Infant wide-field retinal image; camera: Phoenix ICON (100° FOV); 1240x1240:
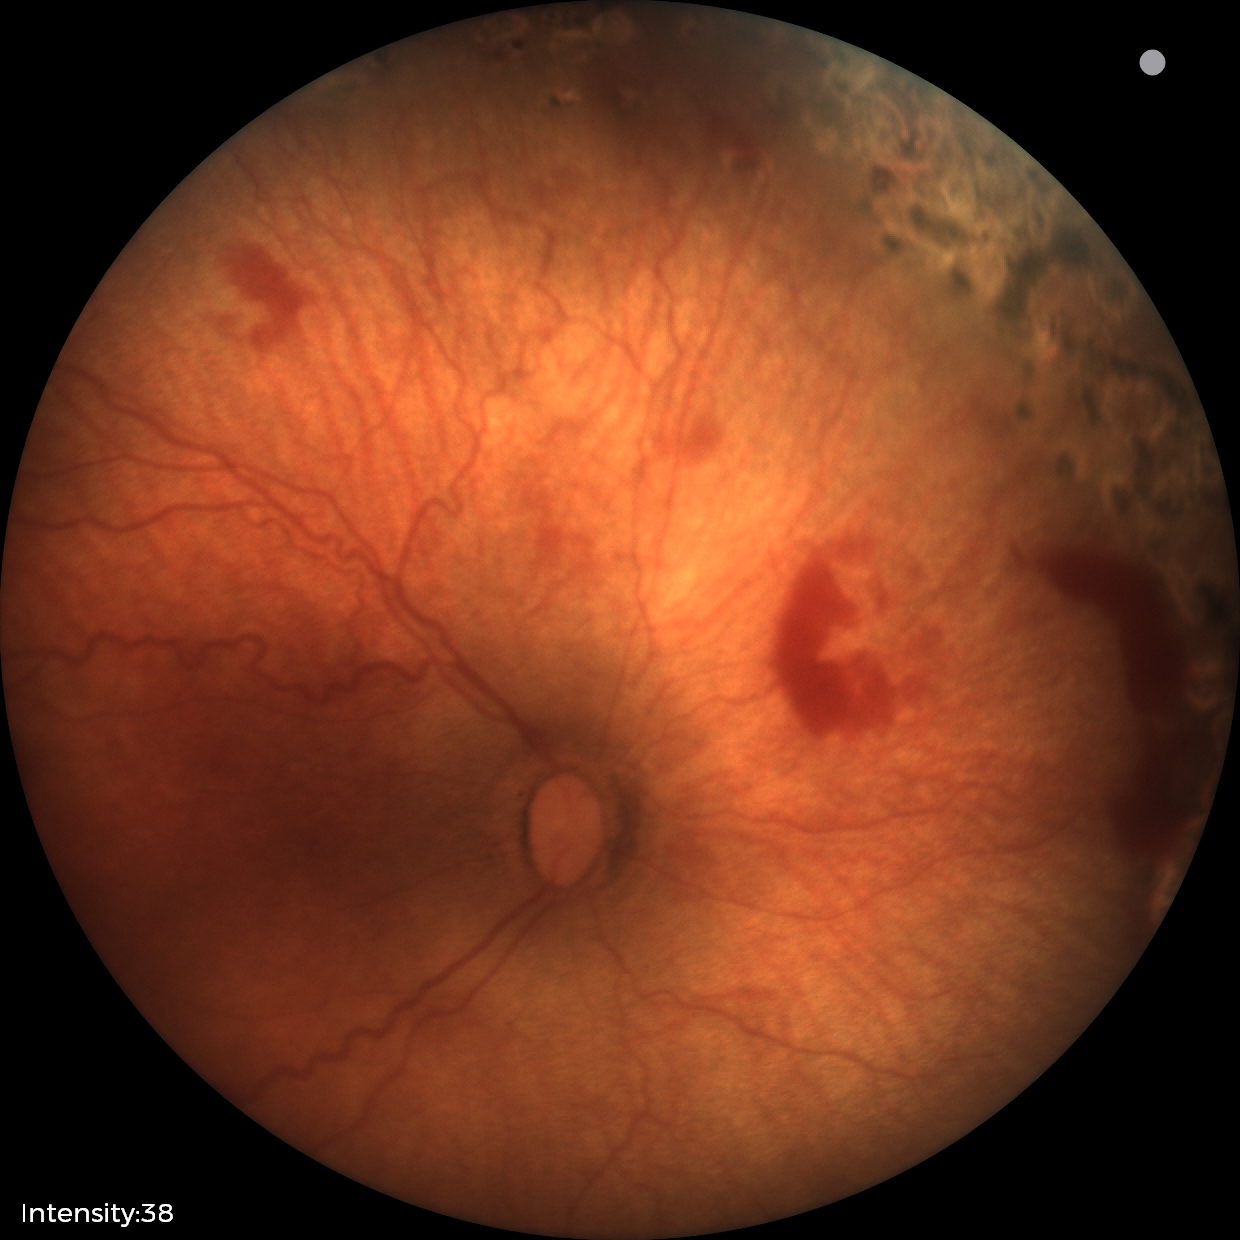 Screening: status post retinopathy of prematurity — retinal appearance after treated retinopathy of prematurity.